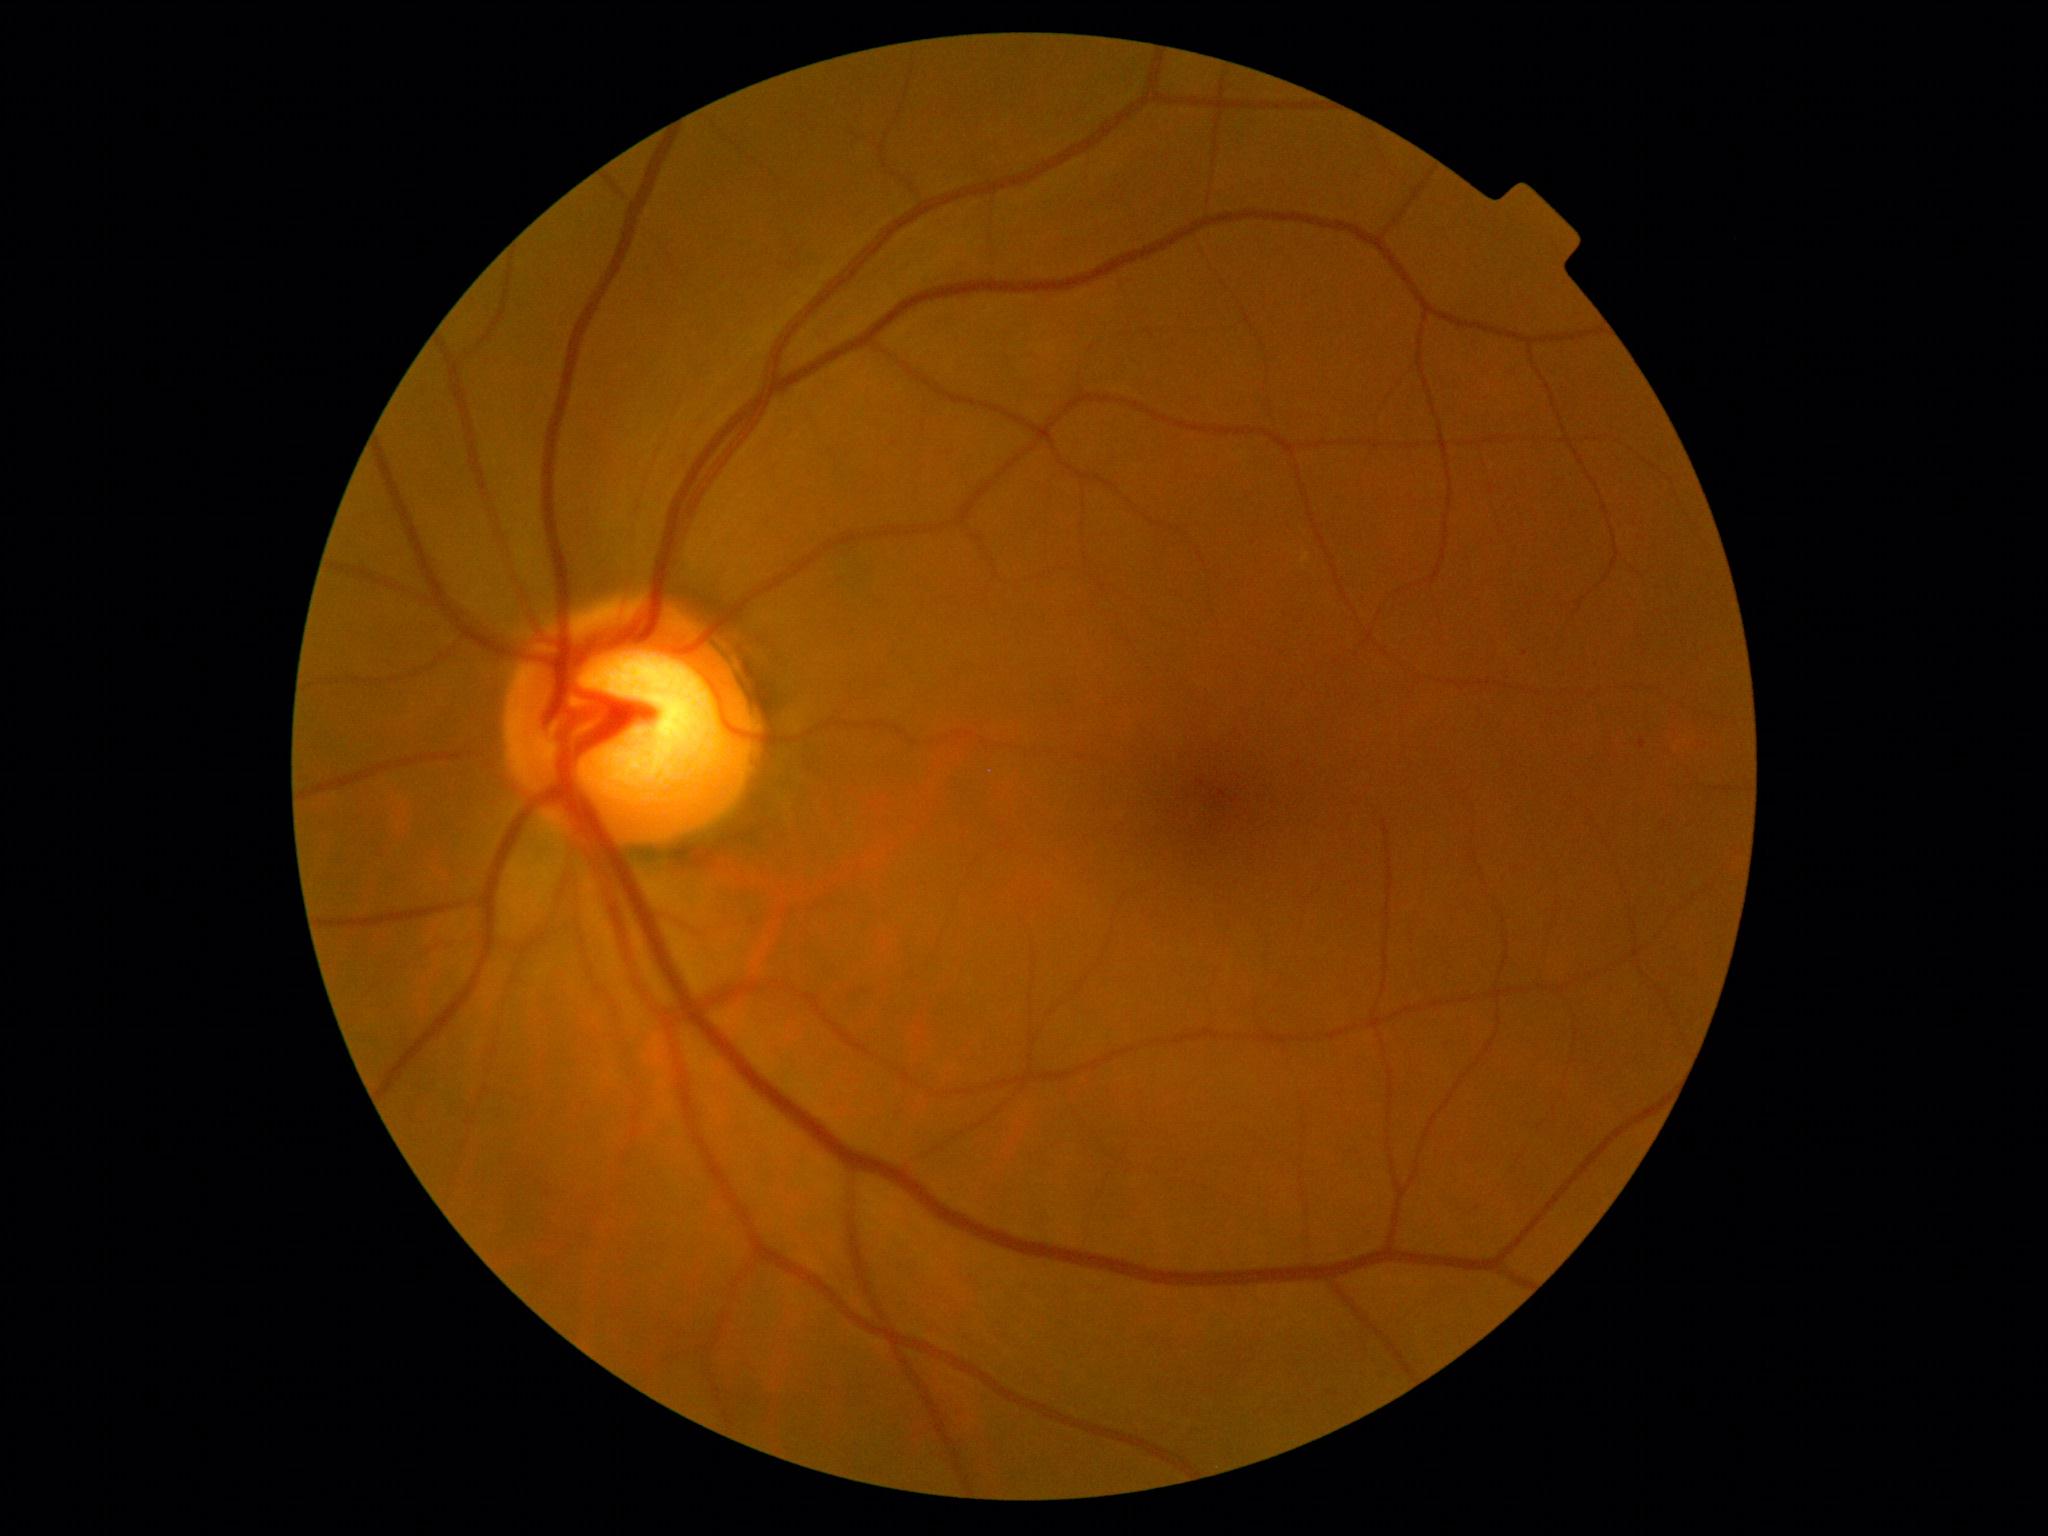
{
  "dr_grade": "grade 0 (no apparent retinopathy) — no visible signs of diabetic retinopathy"
}